2212 x 1659 pixels
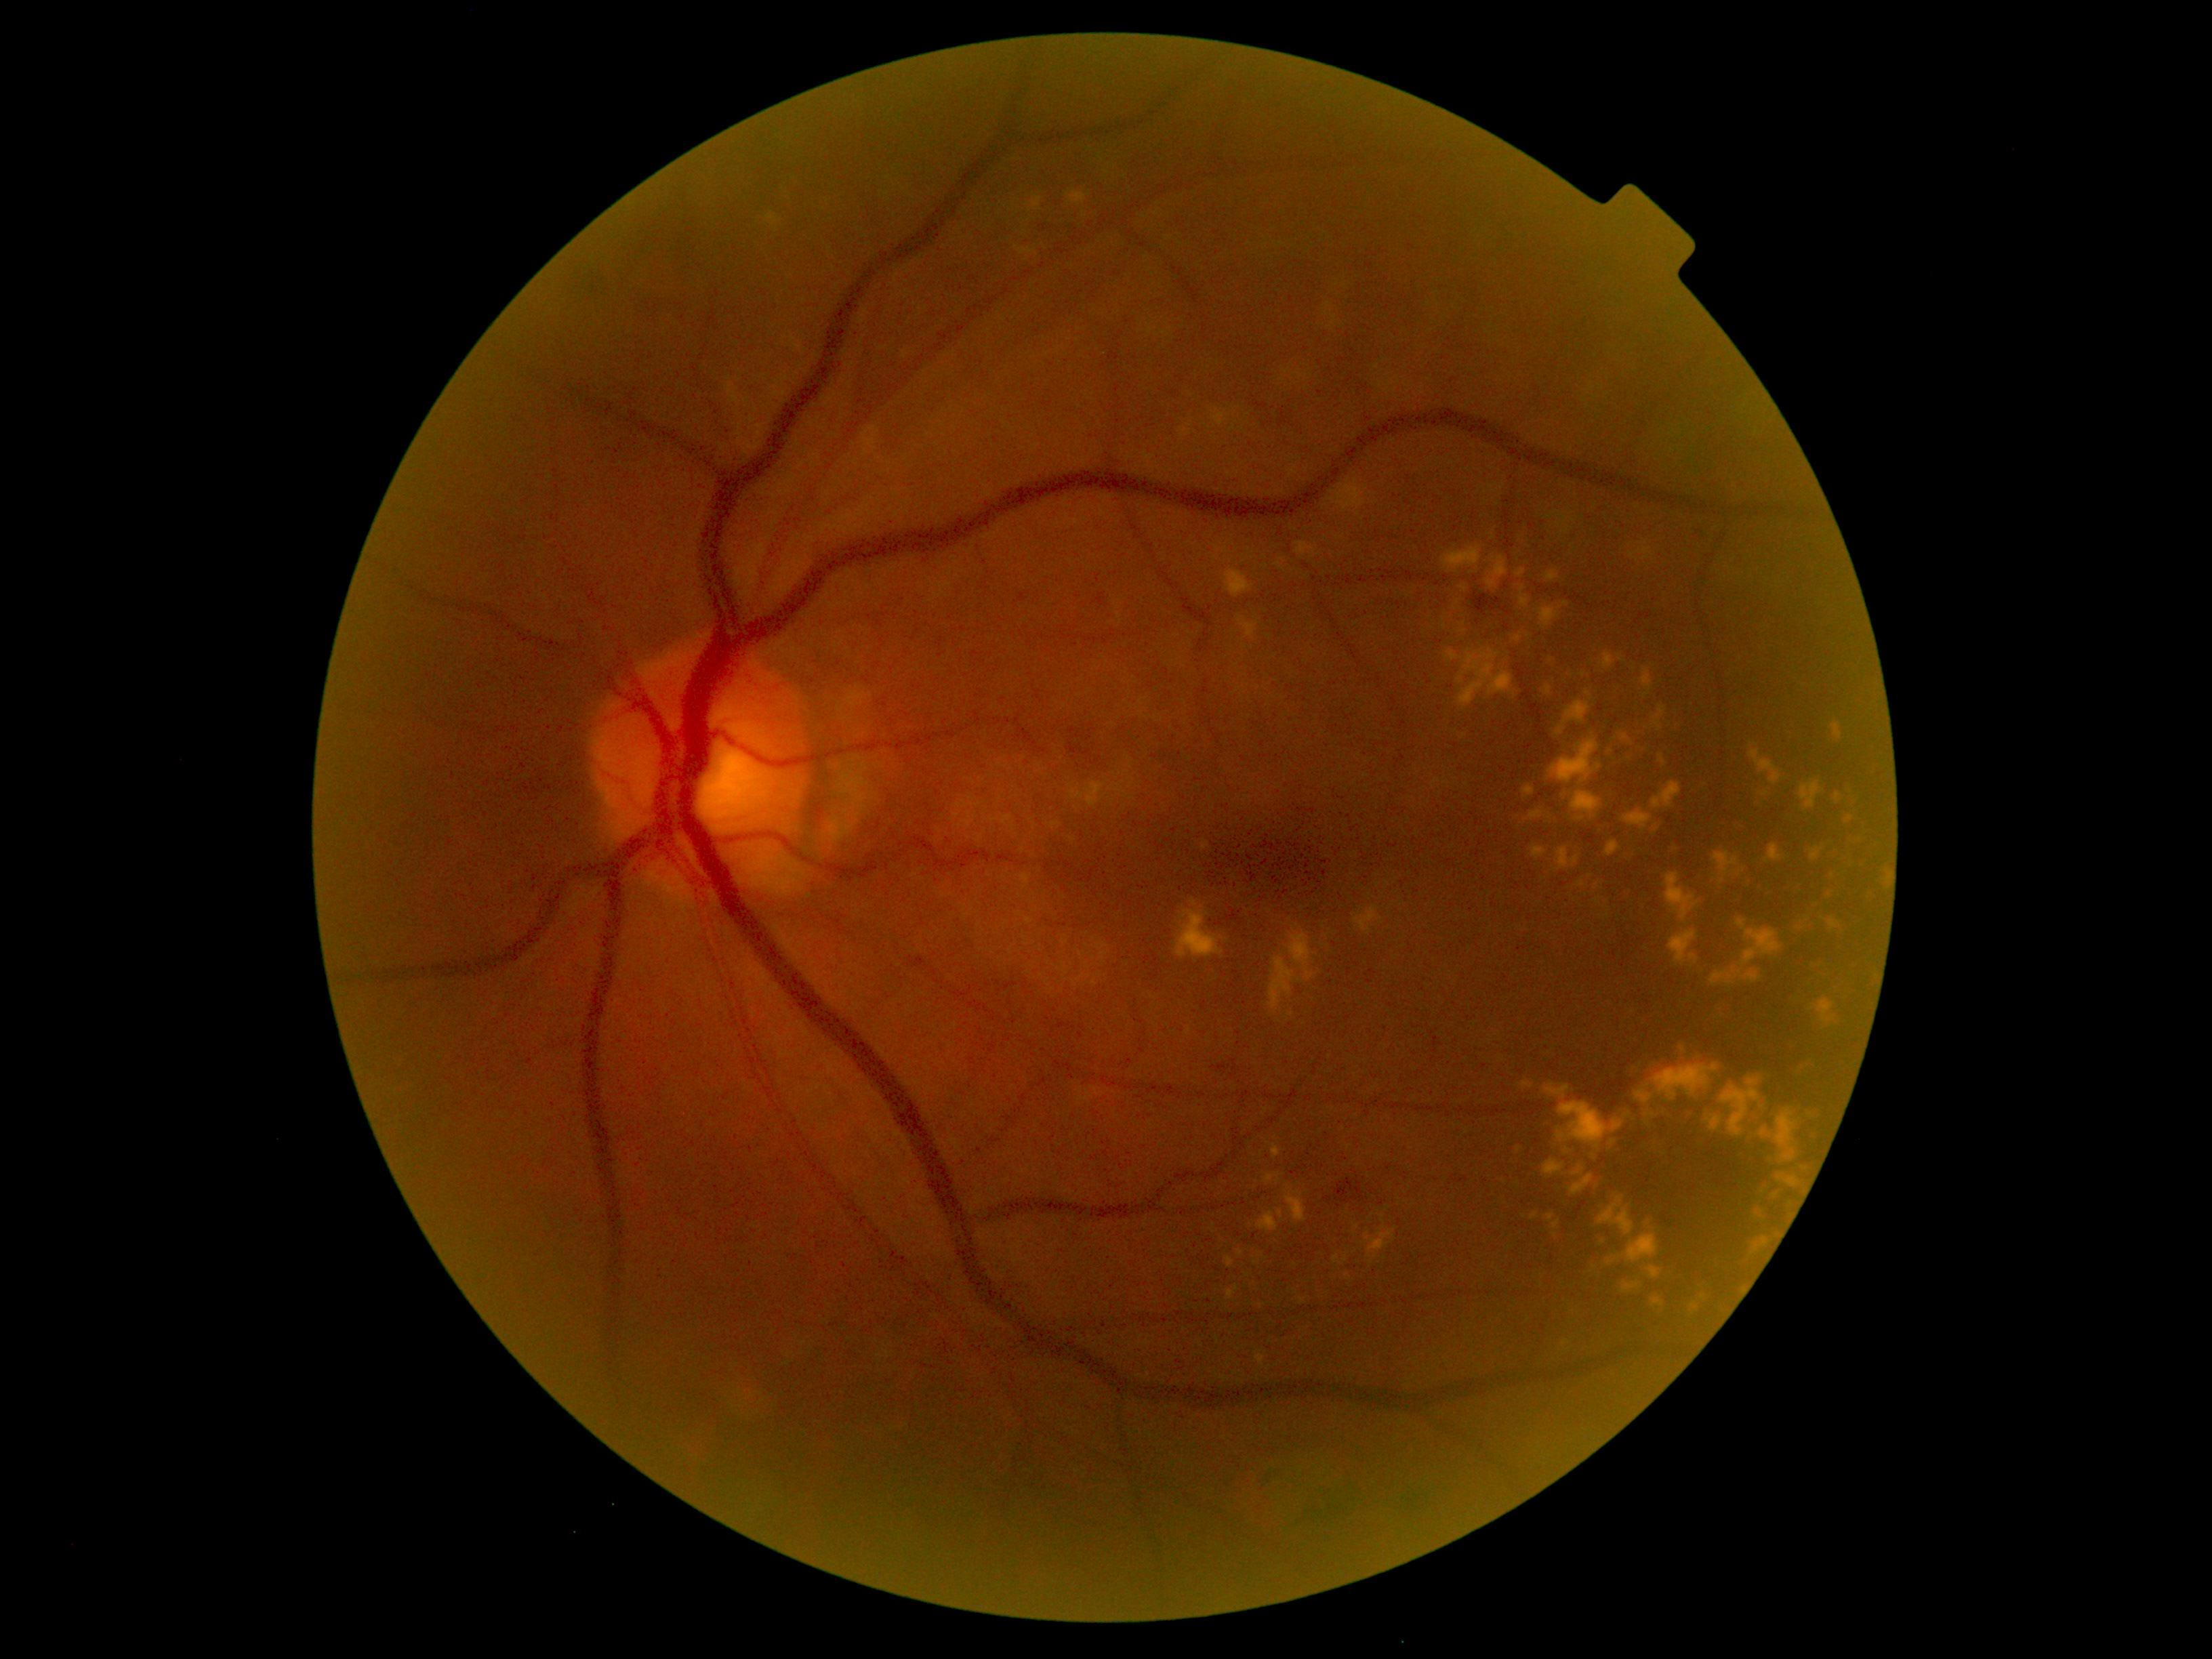
Diabetic retinopathy (DR) is grade 2 (moderate NPDR)
Representative lesions:
• hard exudates (EXs) (partial): BBox(1742, 787, 1887, 1002); BBox(1355, 906, 1385, 936); BBox(1070, 192, 1086, 204); BBox(1333, 1256, 1343, 1265); BBox(1549, 737, 1603, 785); BBox(1764, 844, 1783, 863); BBox(1226, 1287, 1238, 1300); BBox(1364, 1226, 1397, 1264); BBox(1530, 810, 1543, 819); BBox(1441, 546, 1482, 573); BBox(1623, 808, 1653, 830); BBox(1600, 653, 1614, 669); BBox(1666, 841, 1689, 863); BBox(1292, 925, 1302, 932); BBox(1642, 668, 1653, 691)
• Small EXs near 1565:604; 1645:696; 1247:1275; 1346:1259; 1464:737